FOV: 45 degrees:
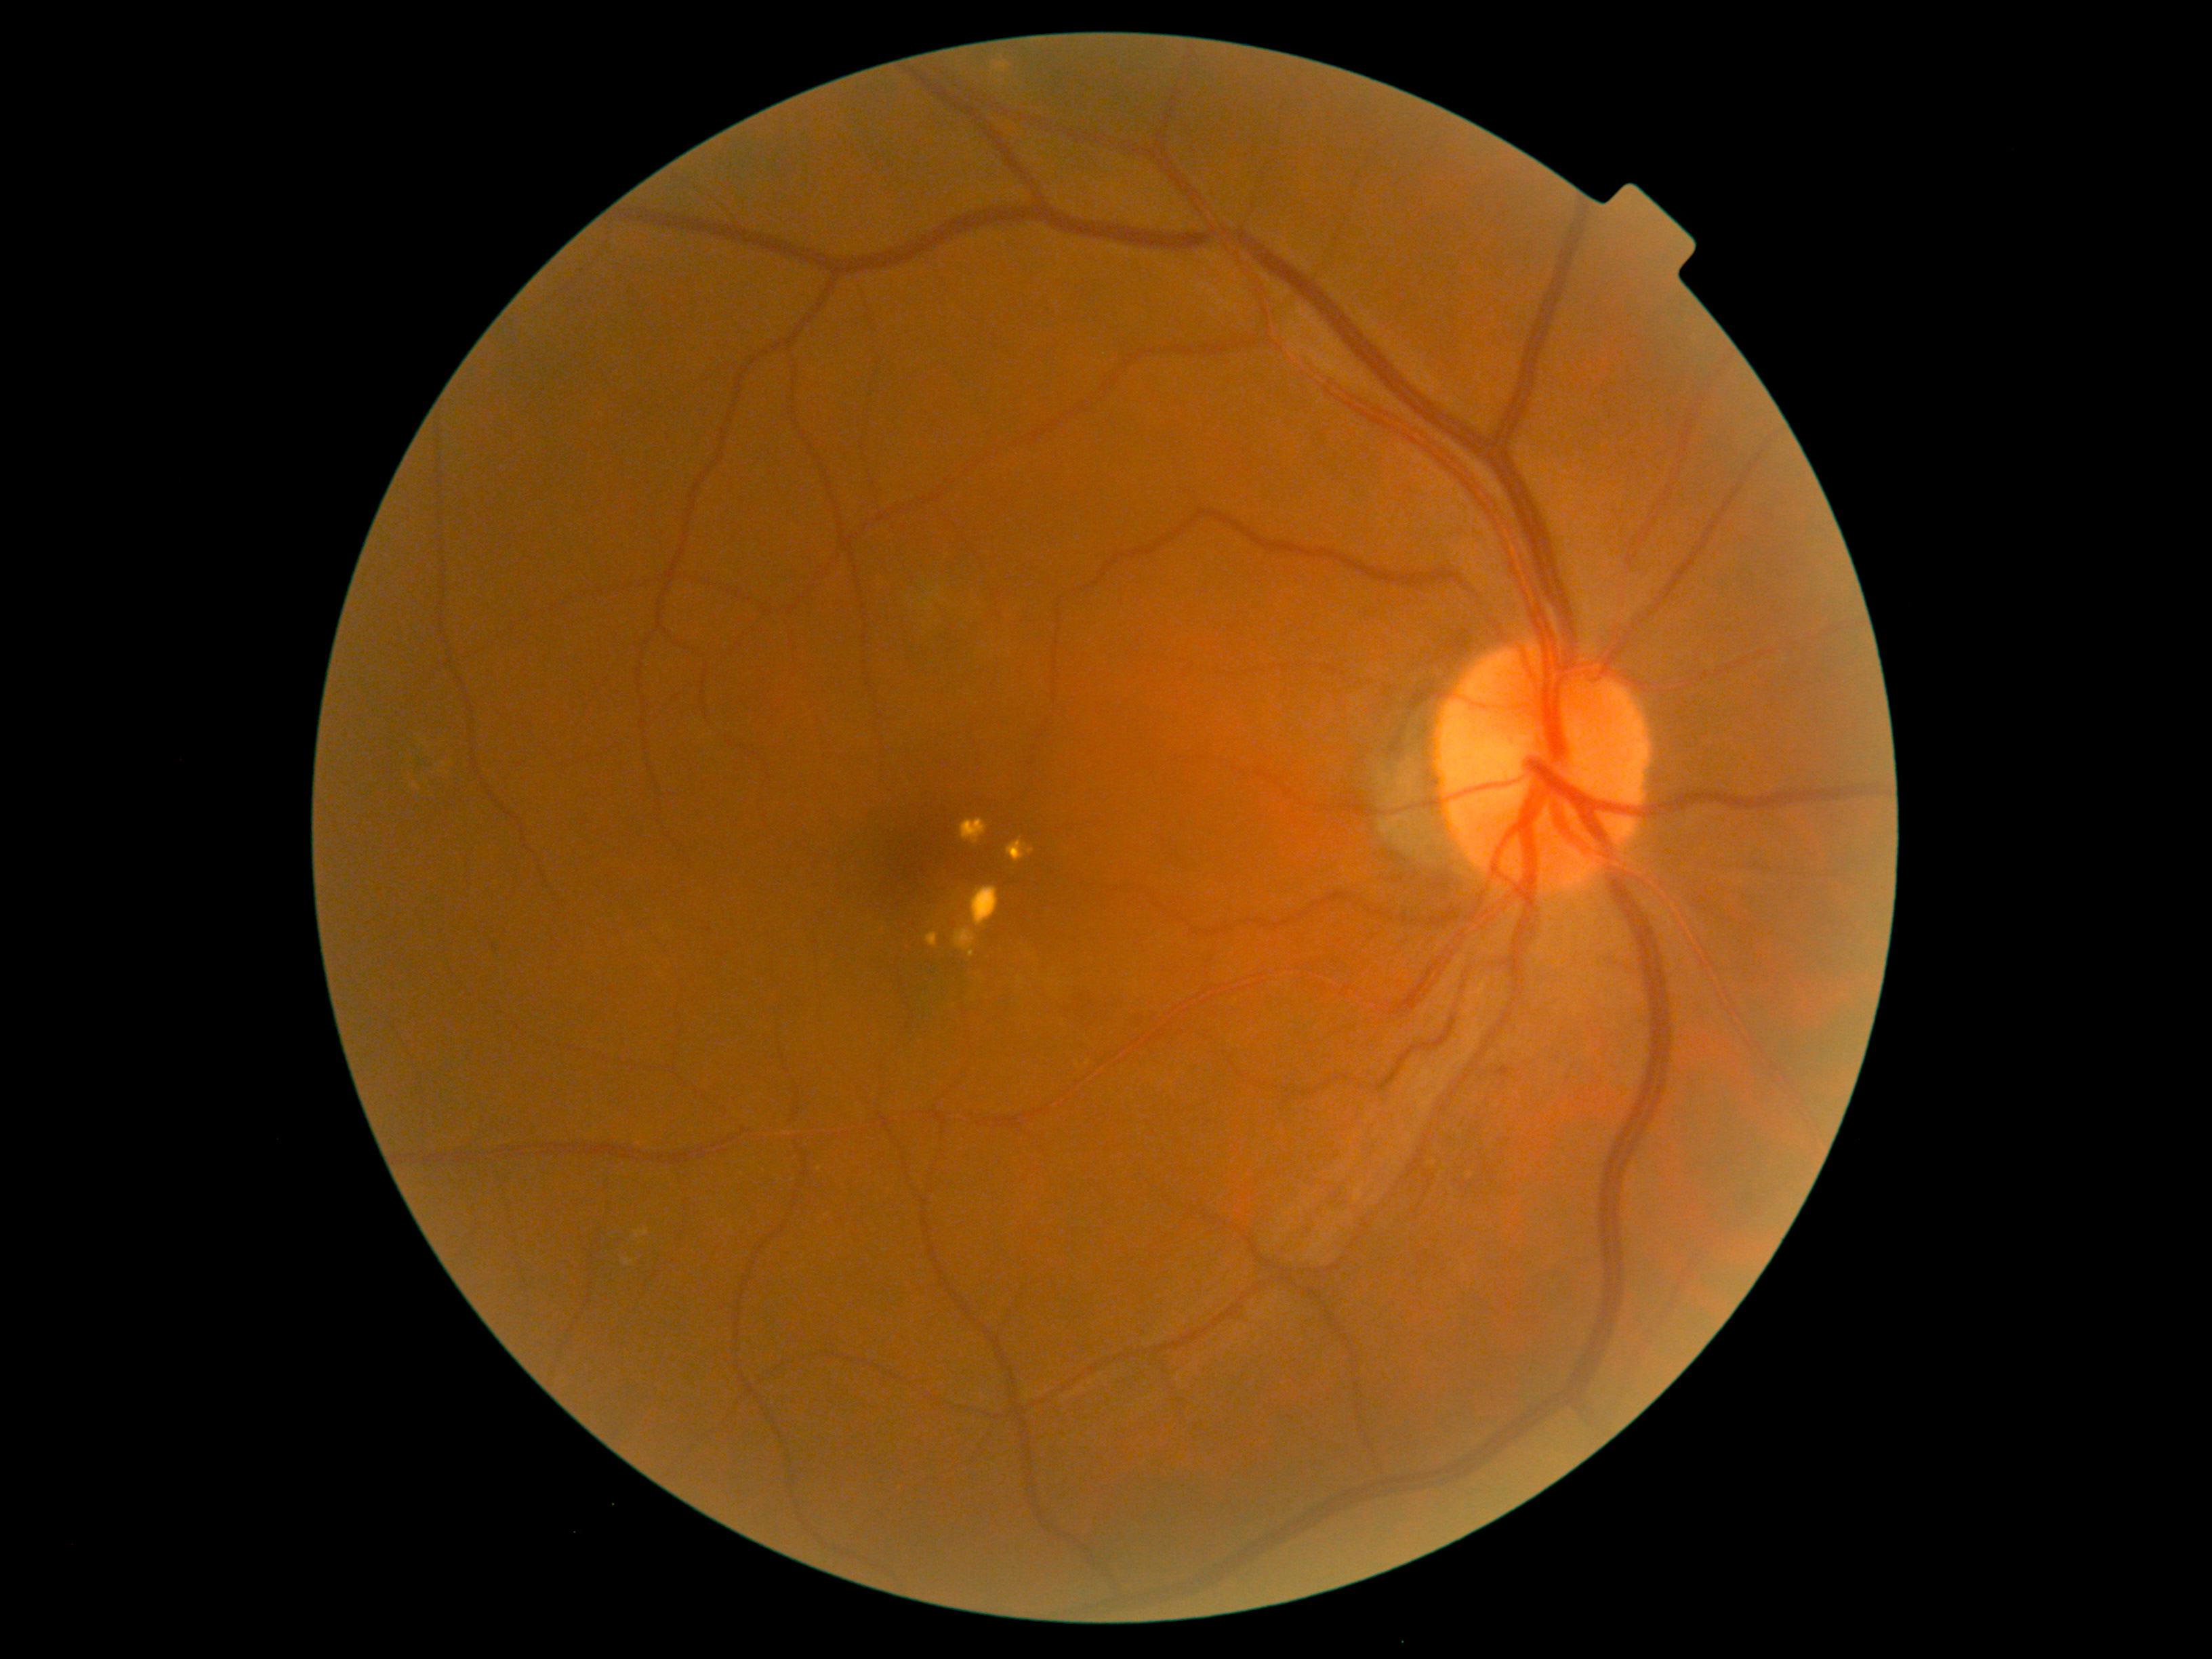 Diabetic retinopathy (DR): grade 2 (moderate NPDR) — more than just microaneurysms but less than severe NPDR
Detected lesions:
- hemorrhages (HEs): not present
- microaneurysms (MAs): <bbox>1500, 1058, 1513, 1077</bbox>
- Smaller MAs around (495; 948)
- soft exudates (SEs): not present
- hard exudates (EXs): <bbox>955, 928, 977, 958</bbox> | <bbox>926, 933, 939, 948</bbox> | <bbox>1008, 838, 1035, 863</bbox> | <bbox>970, 886, 1000, 928</bbox> | <bbox>960, 818, 989, 844</bbox>
- Smaller EXs around (1021; 980)